Modified Davis grading, 848x848 — 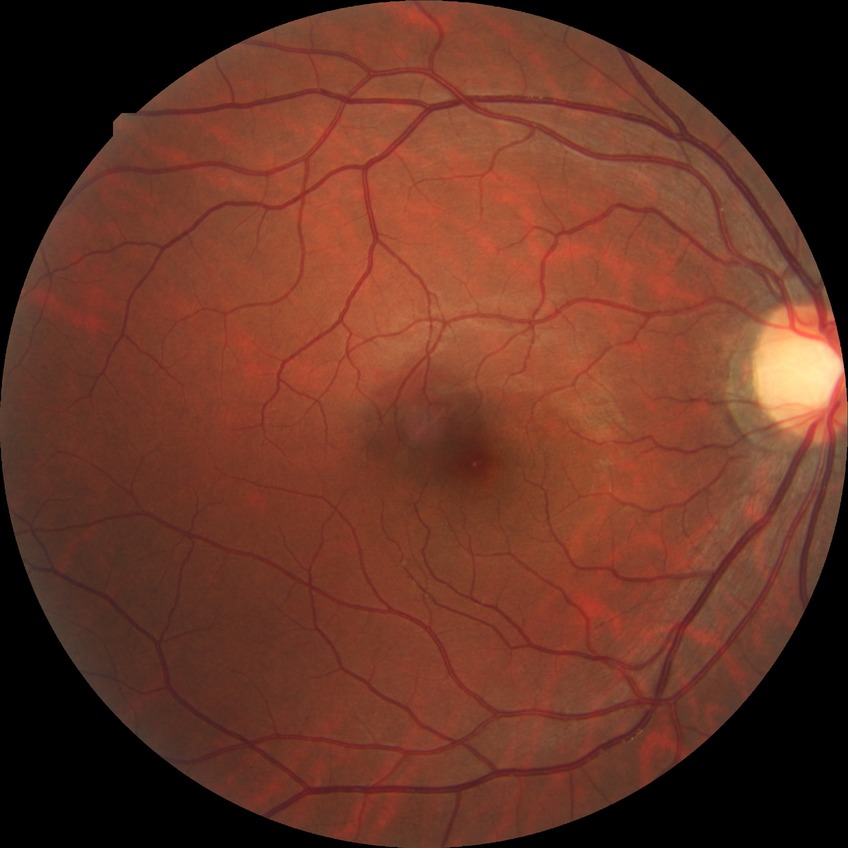

diabetic retinopathy stage = no diabetic retinopathy